Macula-centered field — 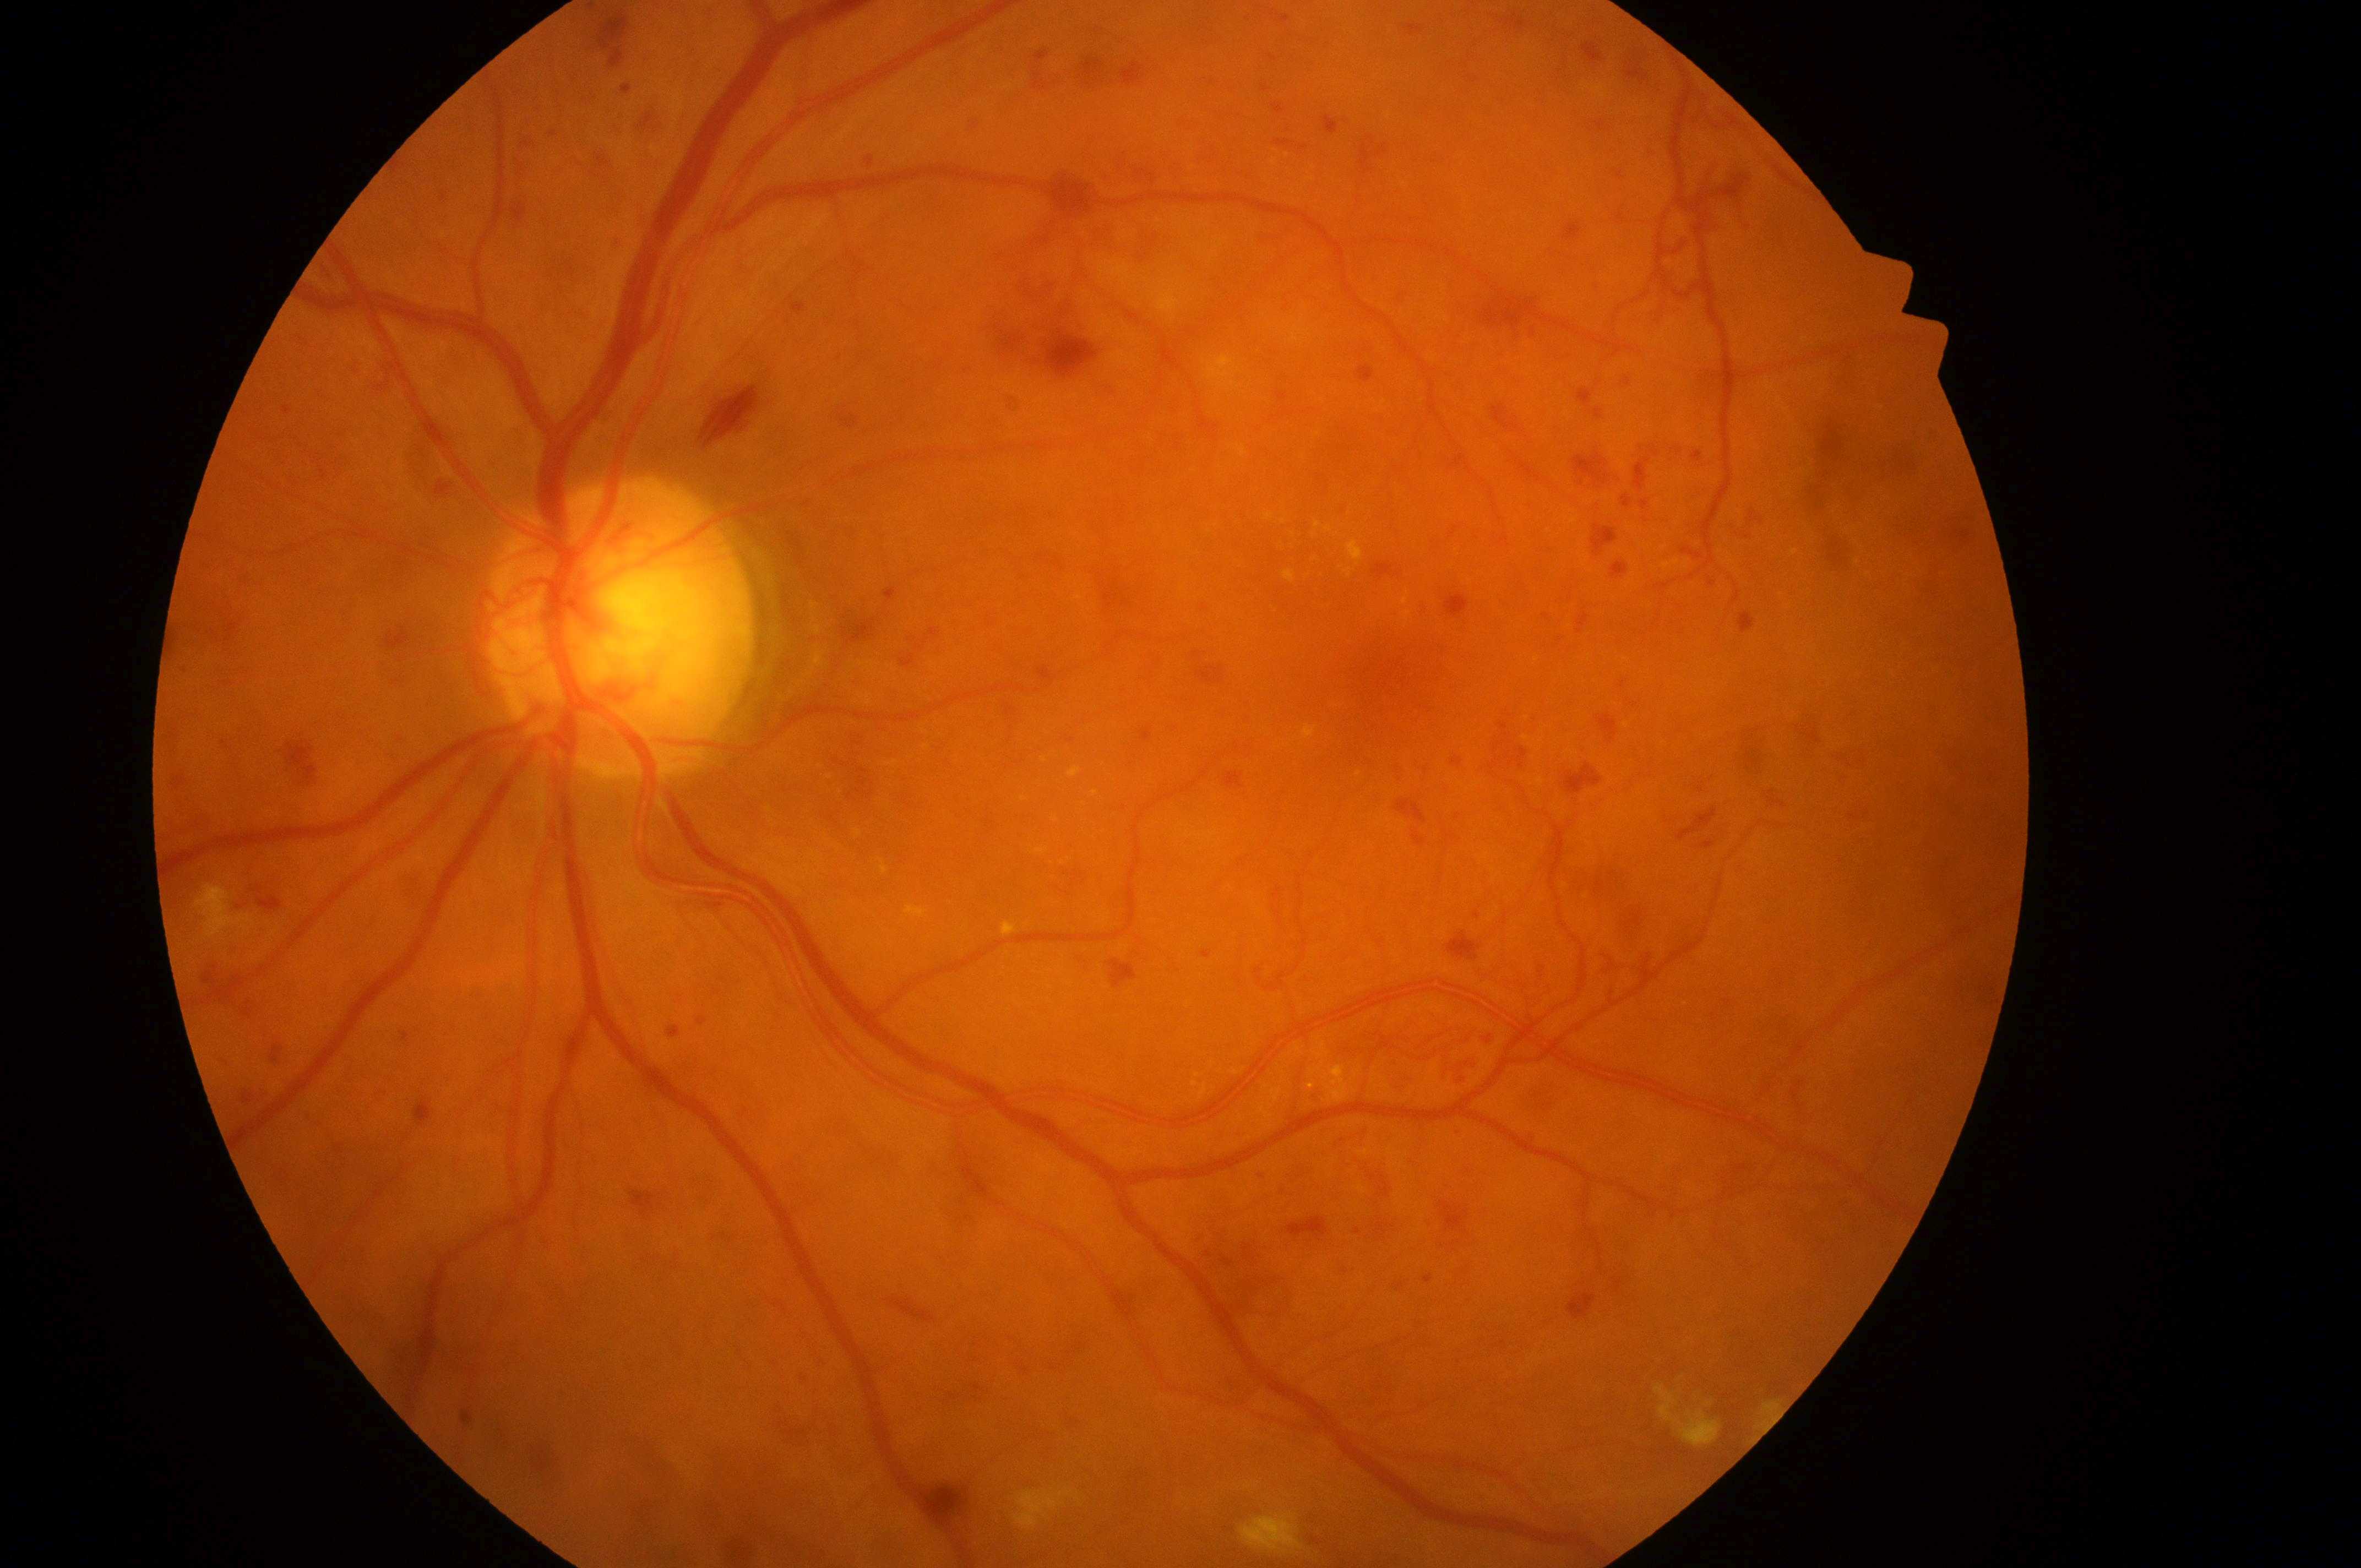

DR grade = 4 (PDR)
DME grade = high risk (2)
fovea = (1384, 672)
optic disc center = (617, 637)
laterality = left